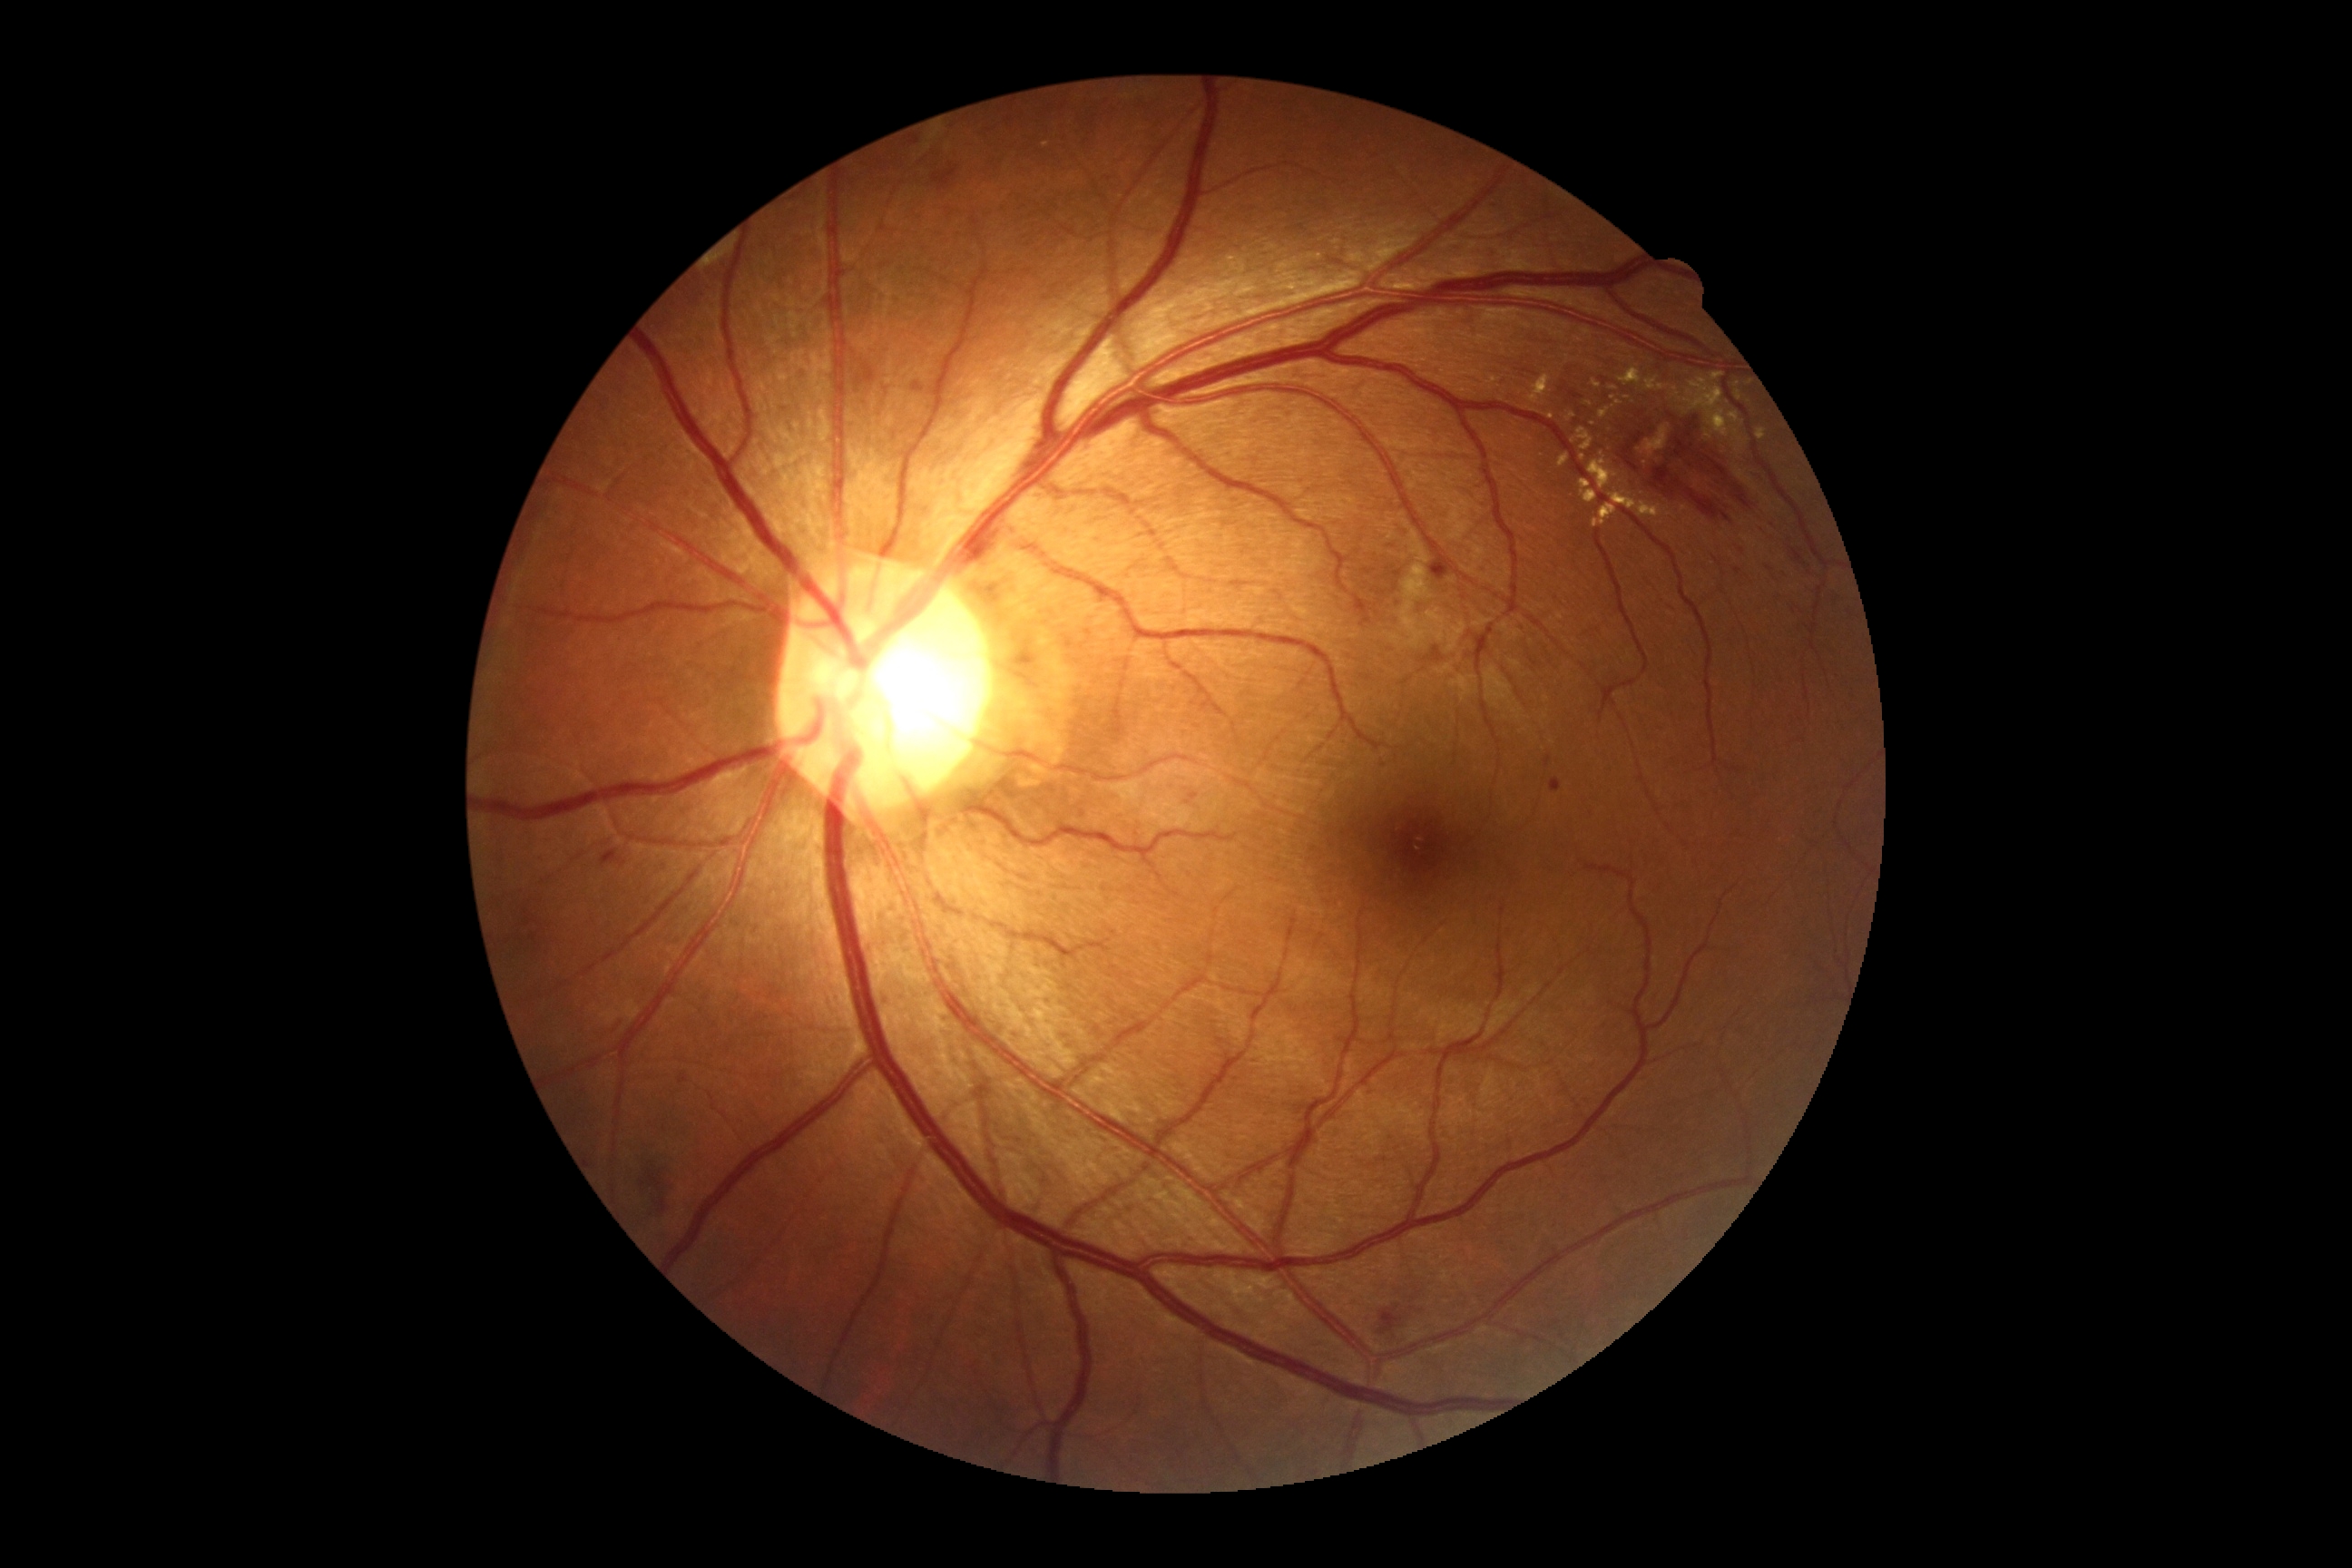
DR class: non-proliferative diabetic retinopathy
DR stage: 2